240 by 240 pixels — 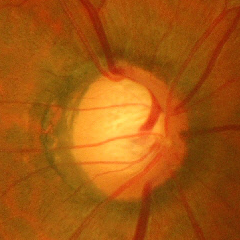 Fundus image with findings of advanced glaucomatous optic neuropathy.